45° field of view, without pupil dilation — 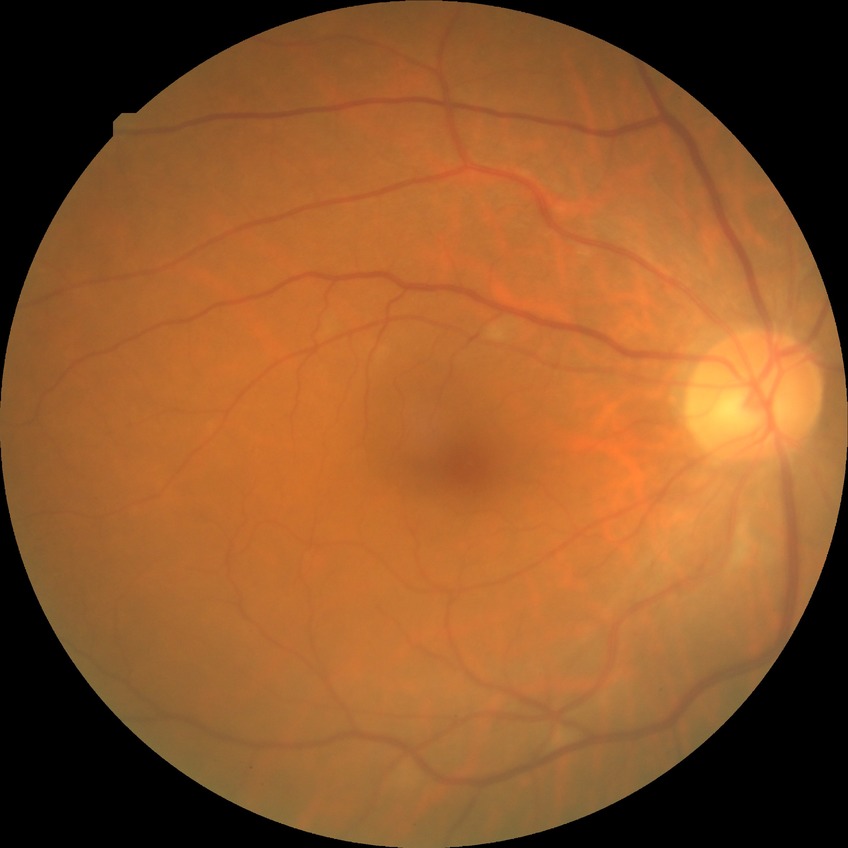
Retinopathy grade is no diabetic retinopathy.